Camera: Natus RetCam Envision (130° FOV). Pediatric retinal photograph (wide-field):
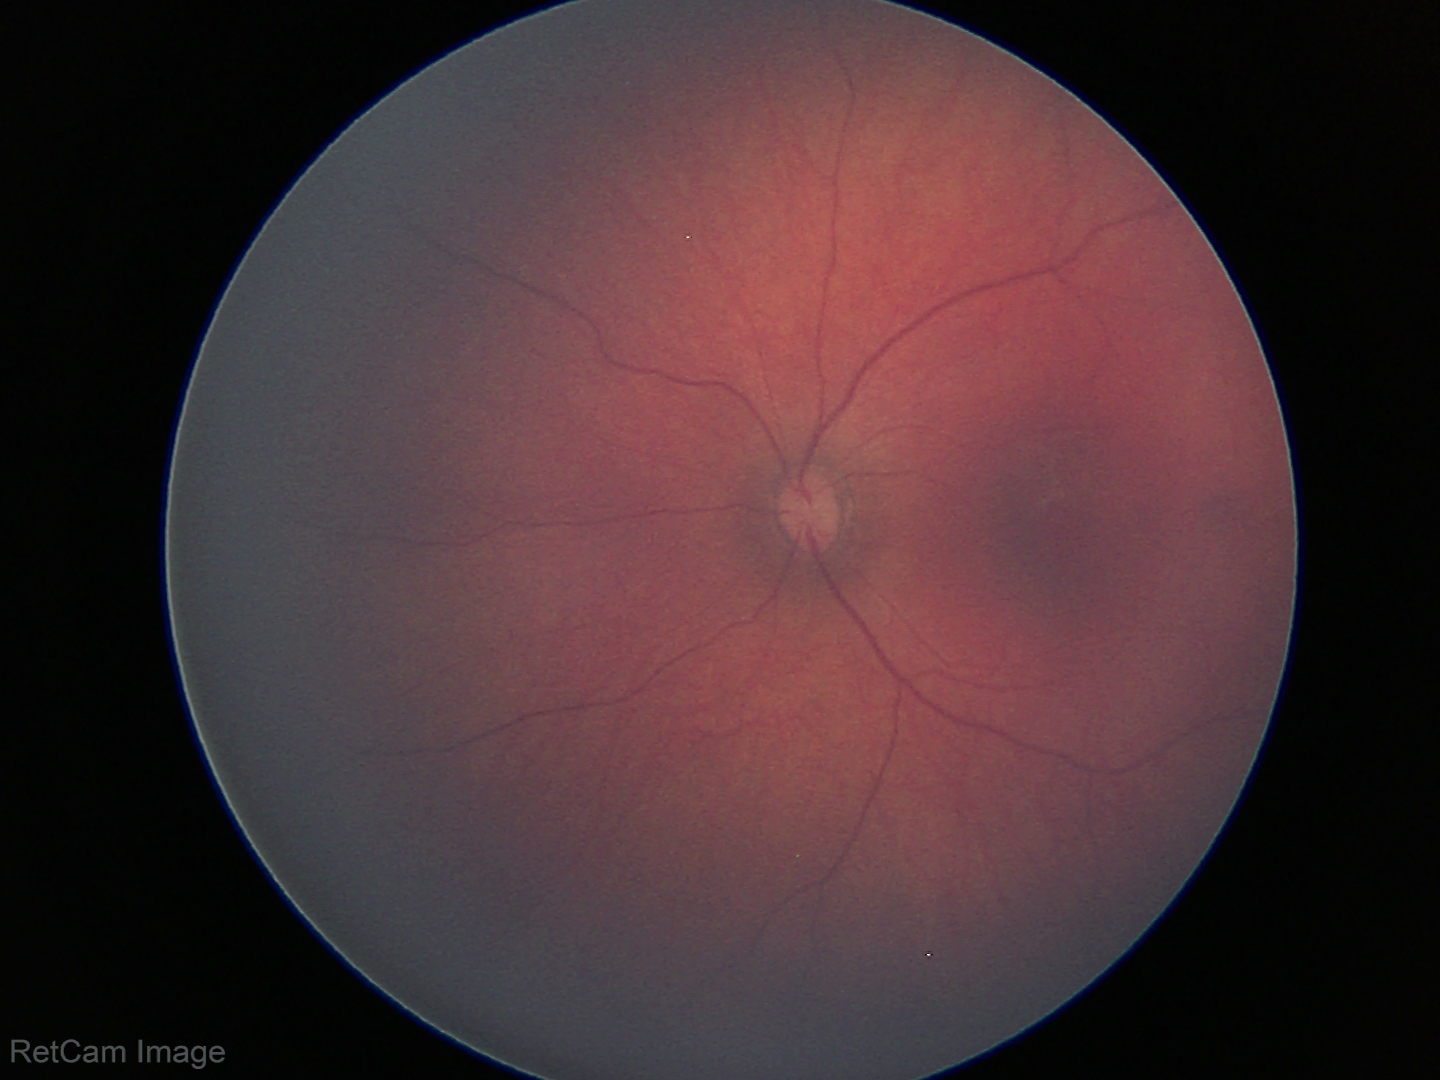

Normal screening examination.